Handheld portable fundus camera image:
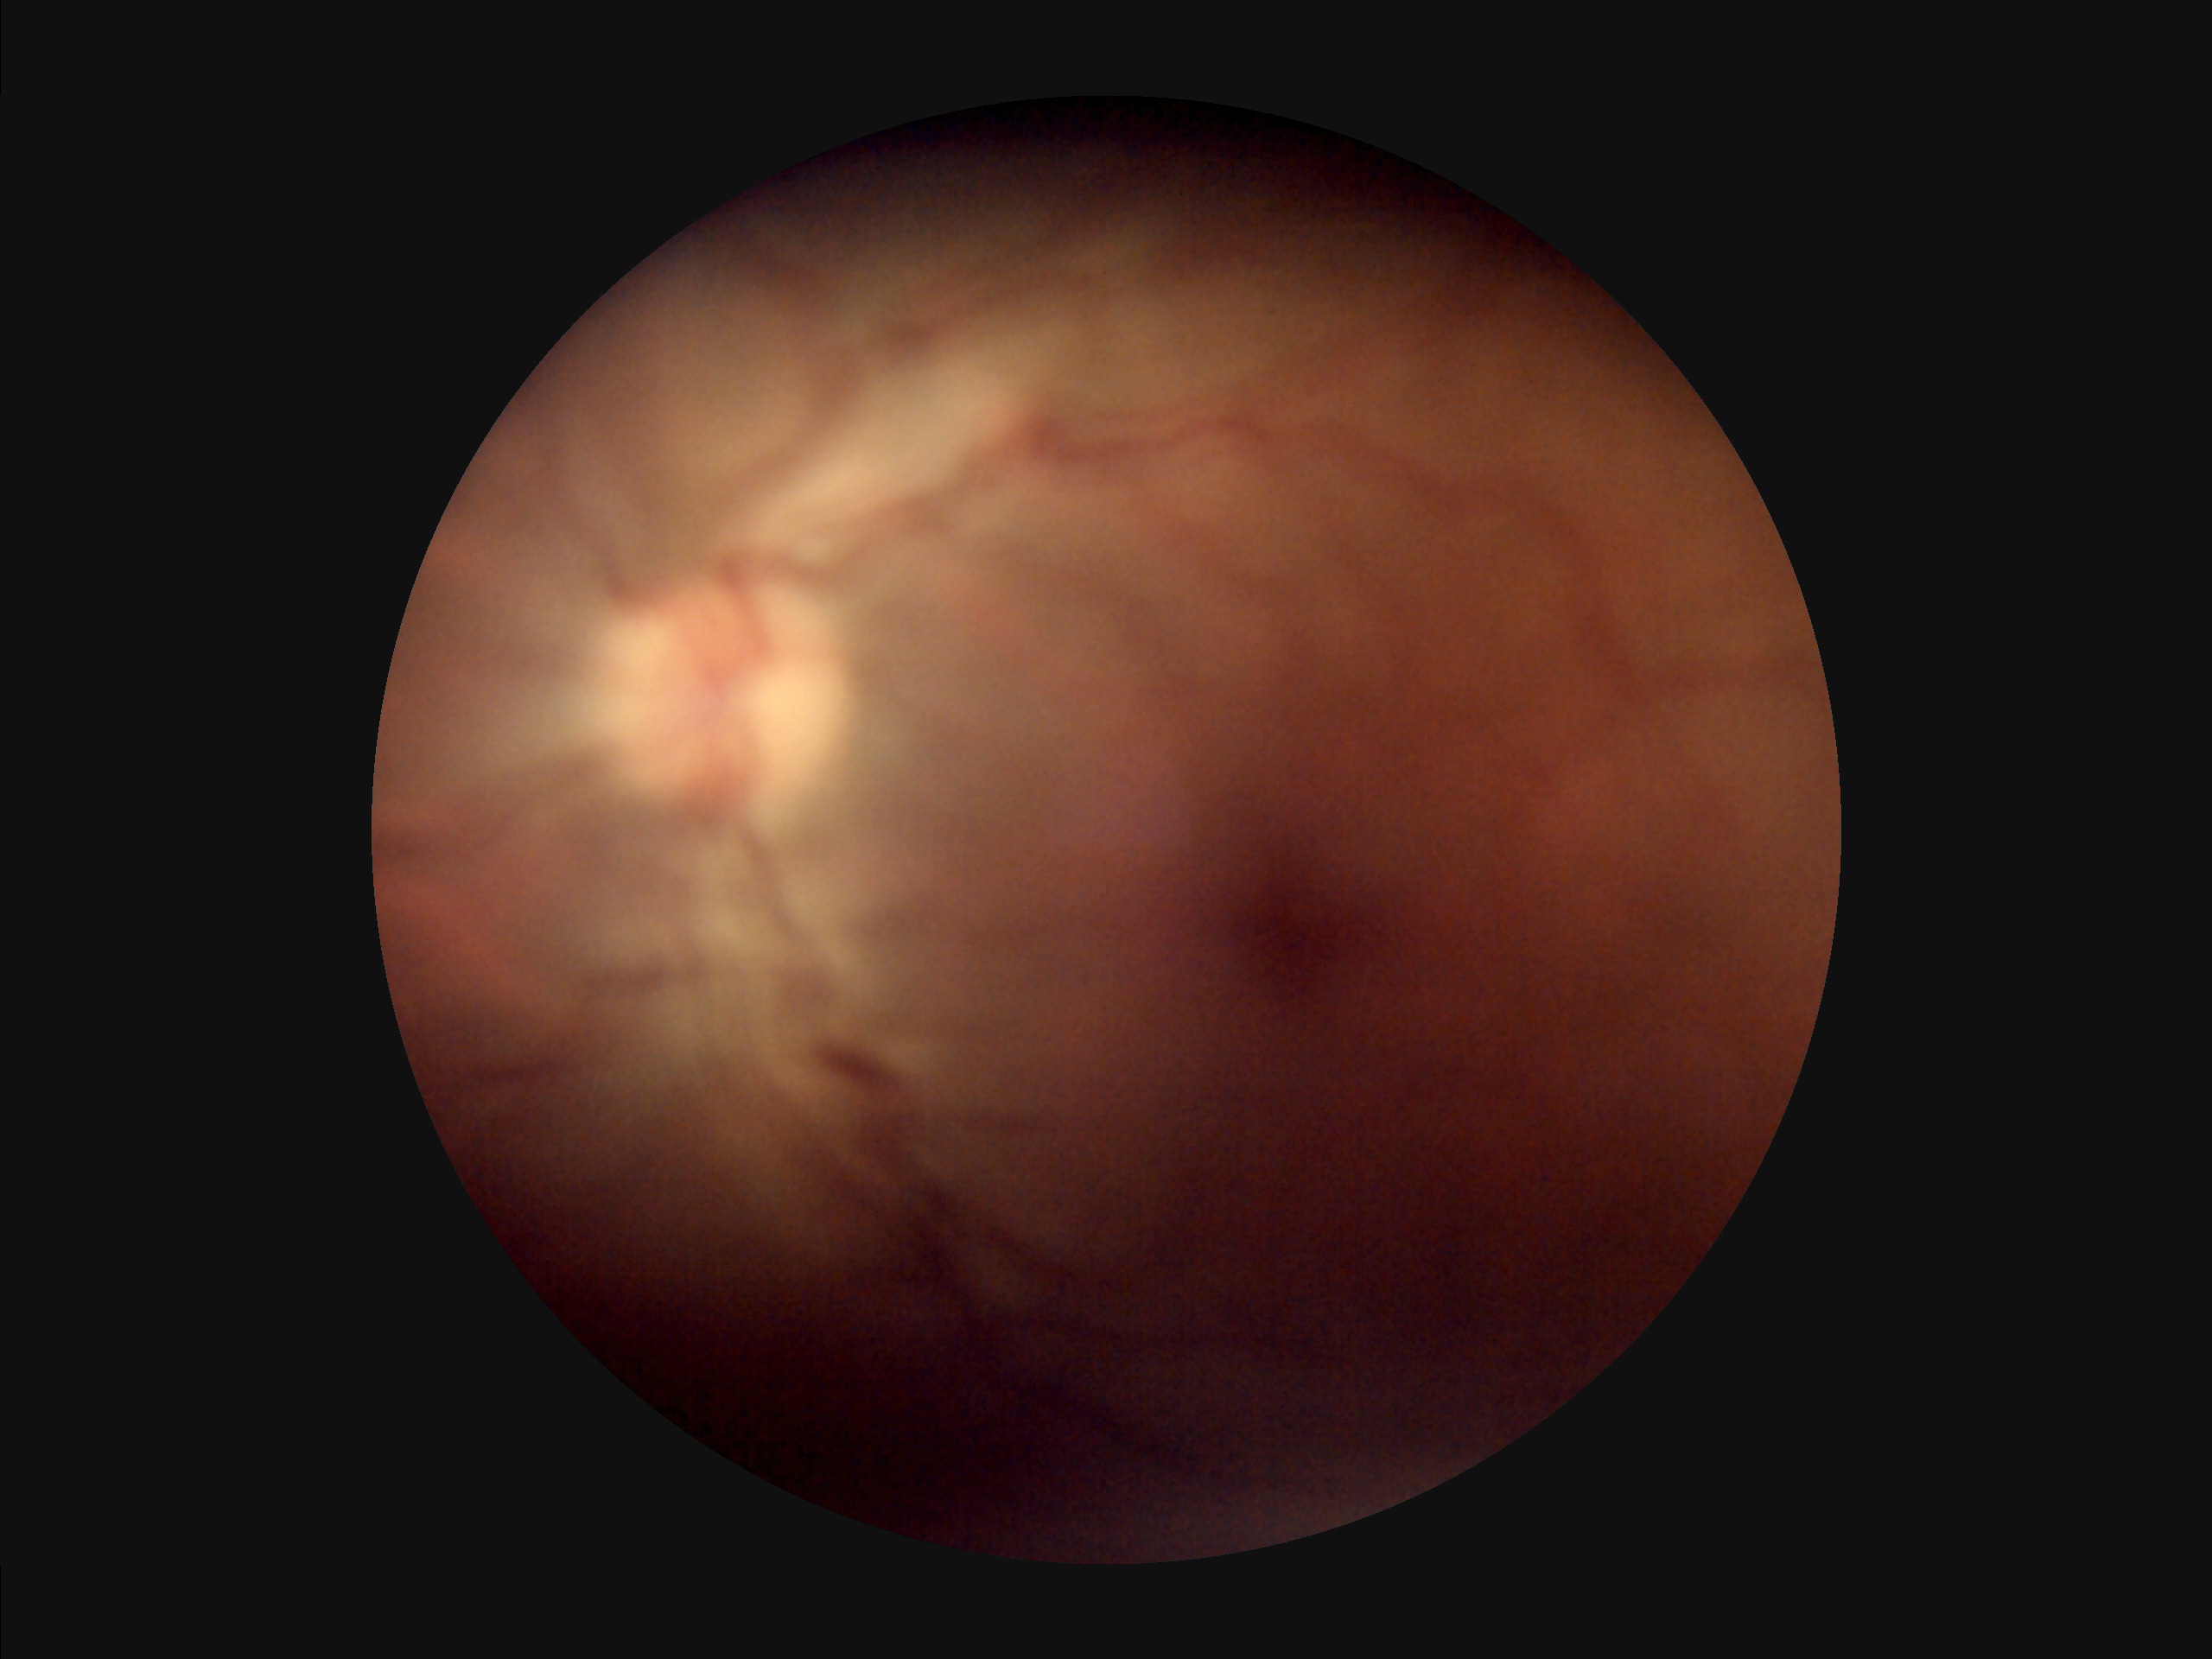
Sharpness = out of focus; Contrast = poor; Overall image quality = low; Illumination = poor.